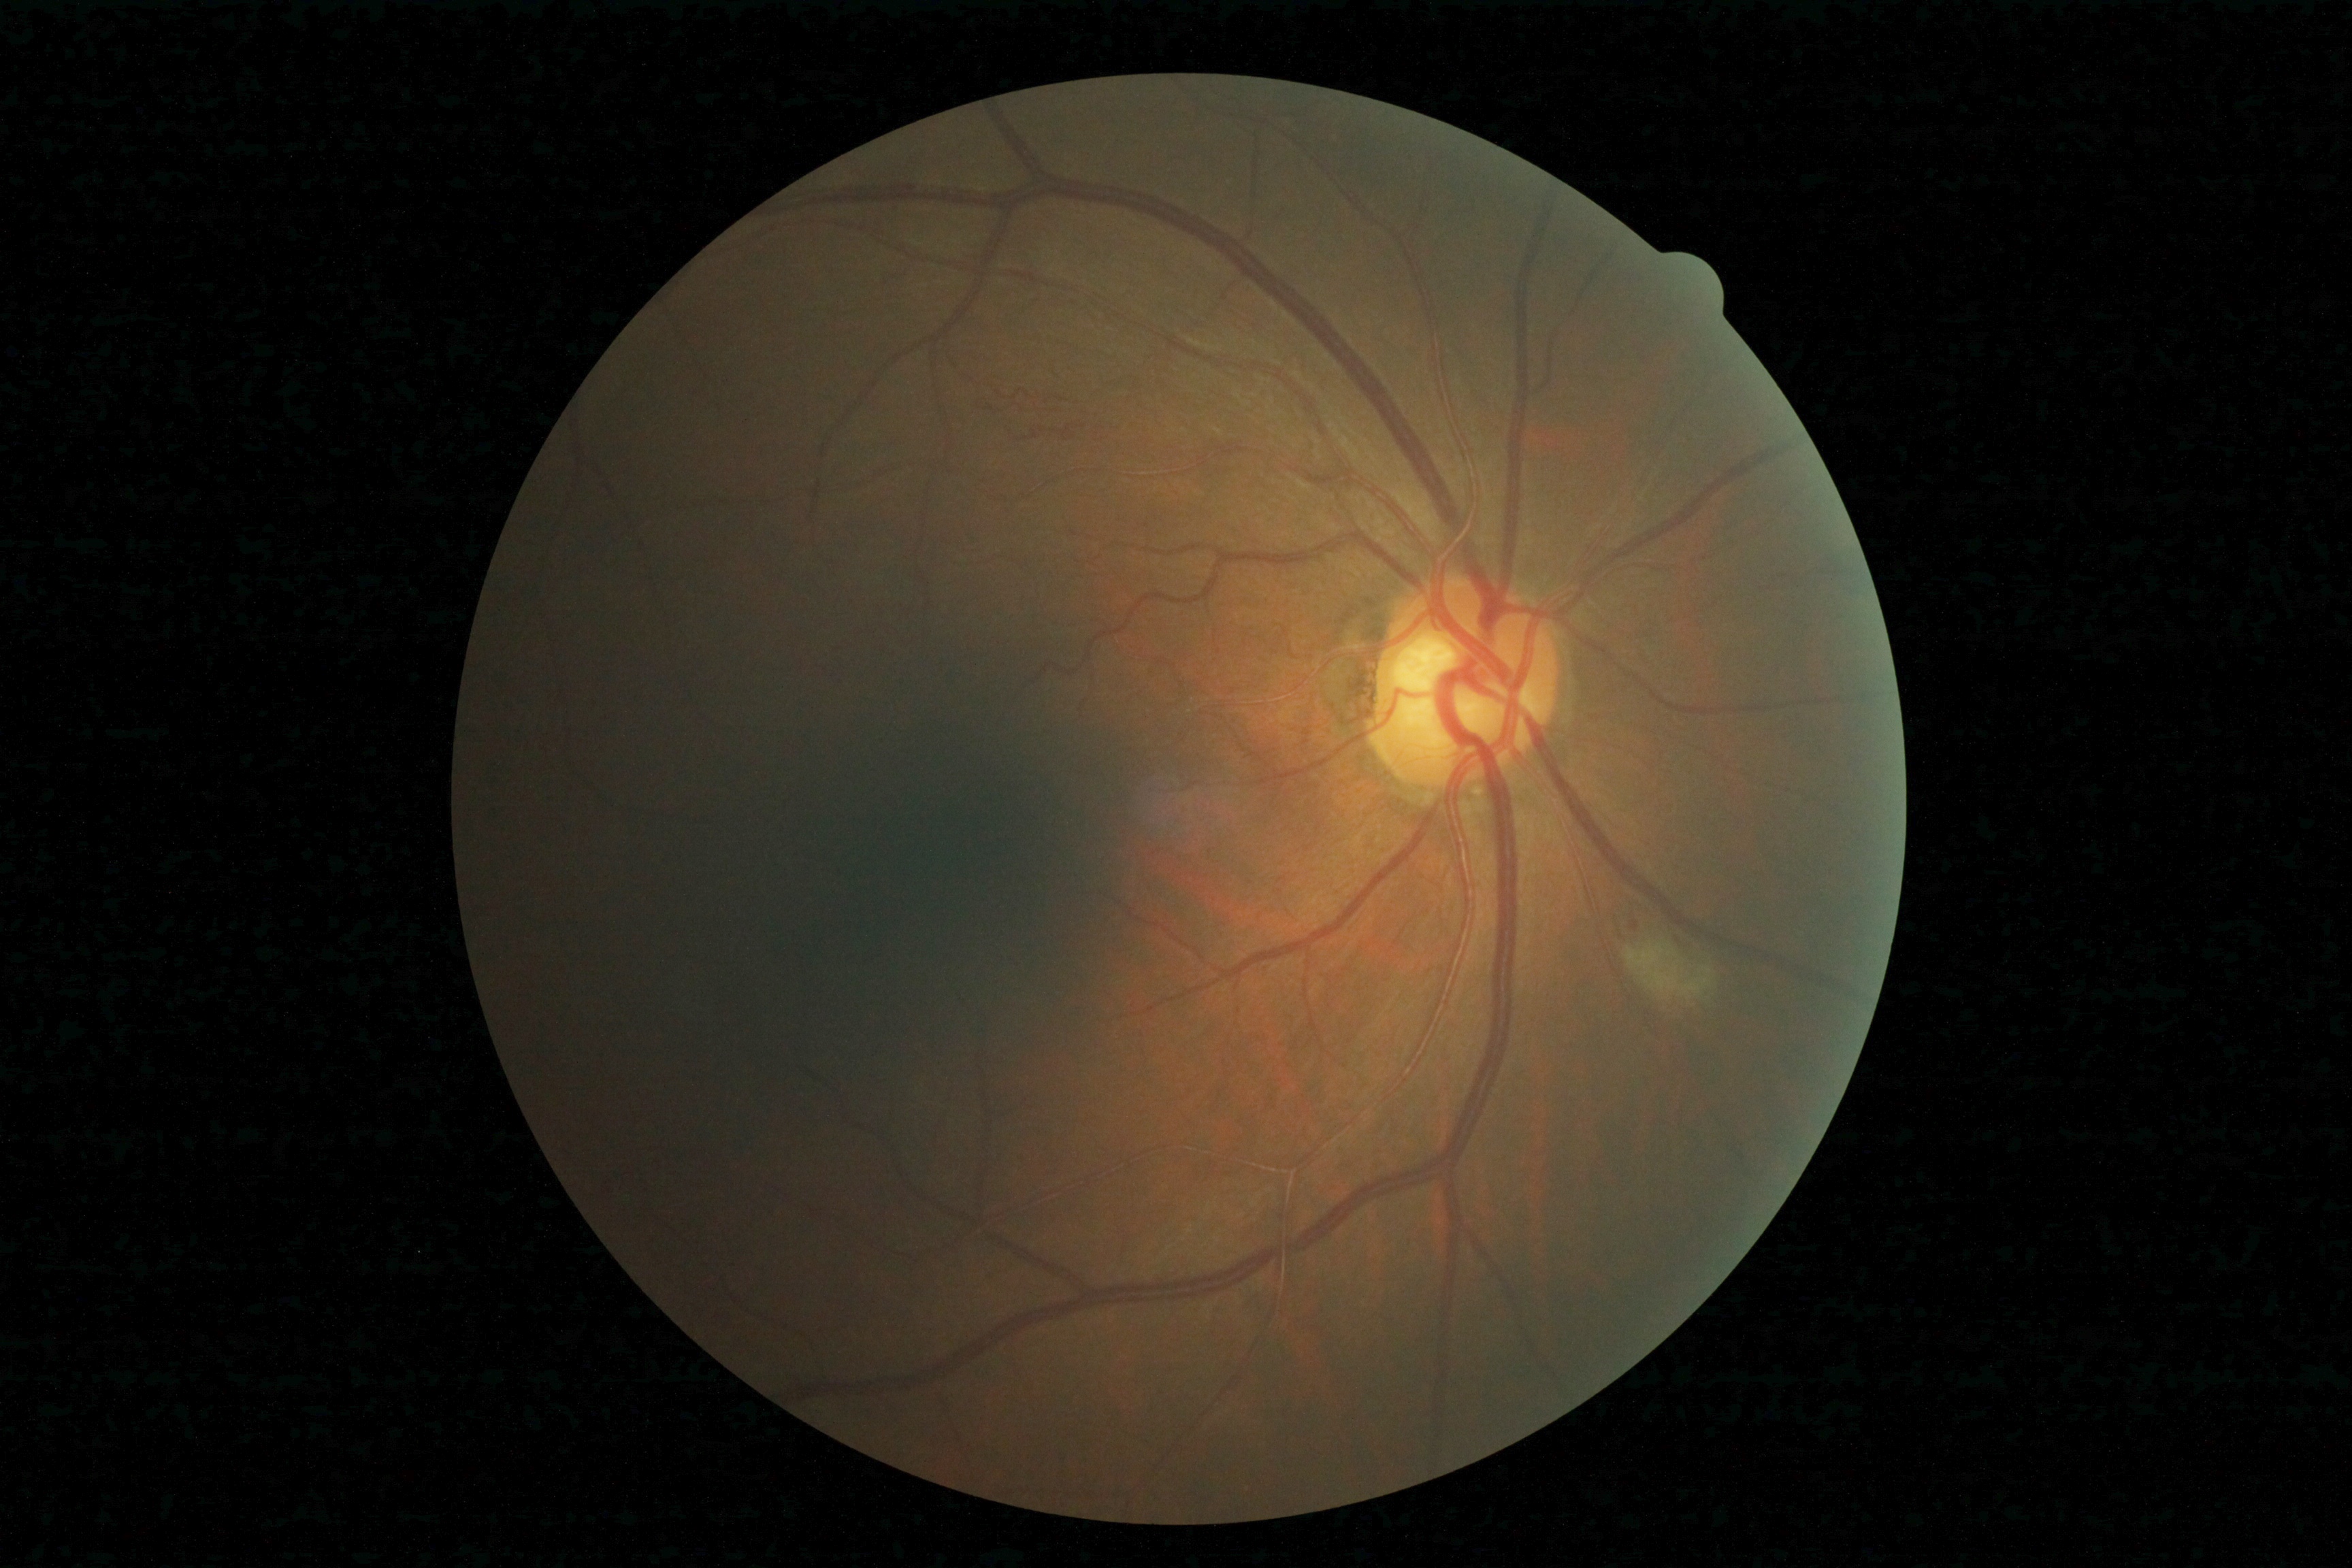
{
  "dr_grade": "3 — more than 20 intraretinal hemorrhages in each of 4 quadrants, definite venous beading in 2 or more quadrants, or prominent intraretinal microvascular abnormalities in 1 or more quadrants, with no signs of proliferative retinopathy"
}